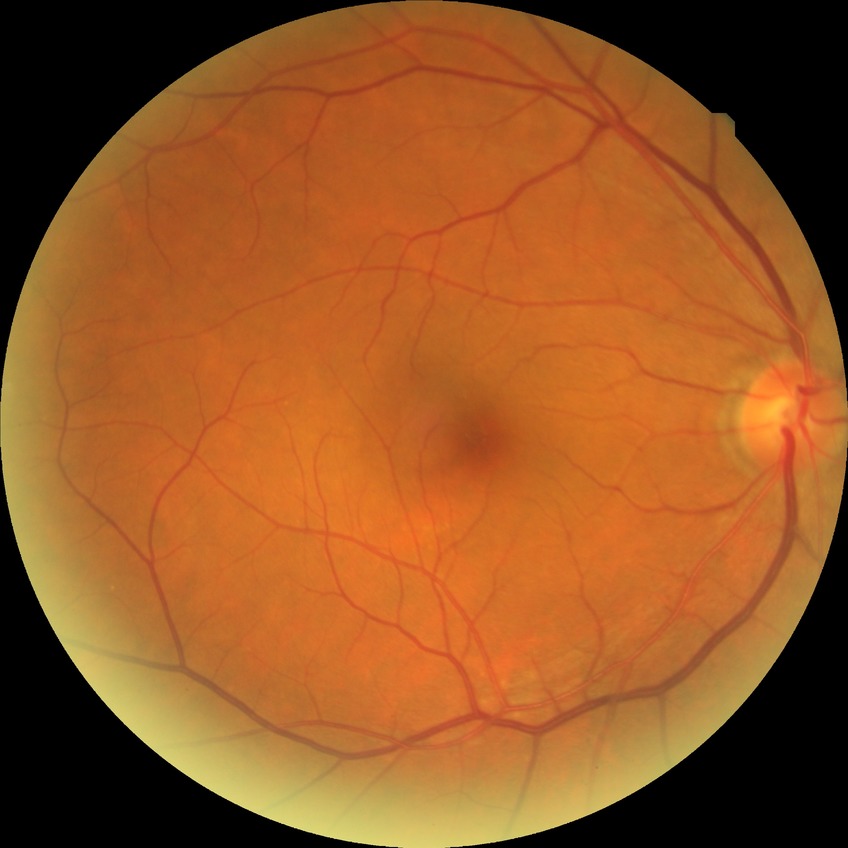
Diabetic retinopathy (DR): no diabetic retinopathy (NDR).